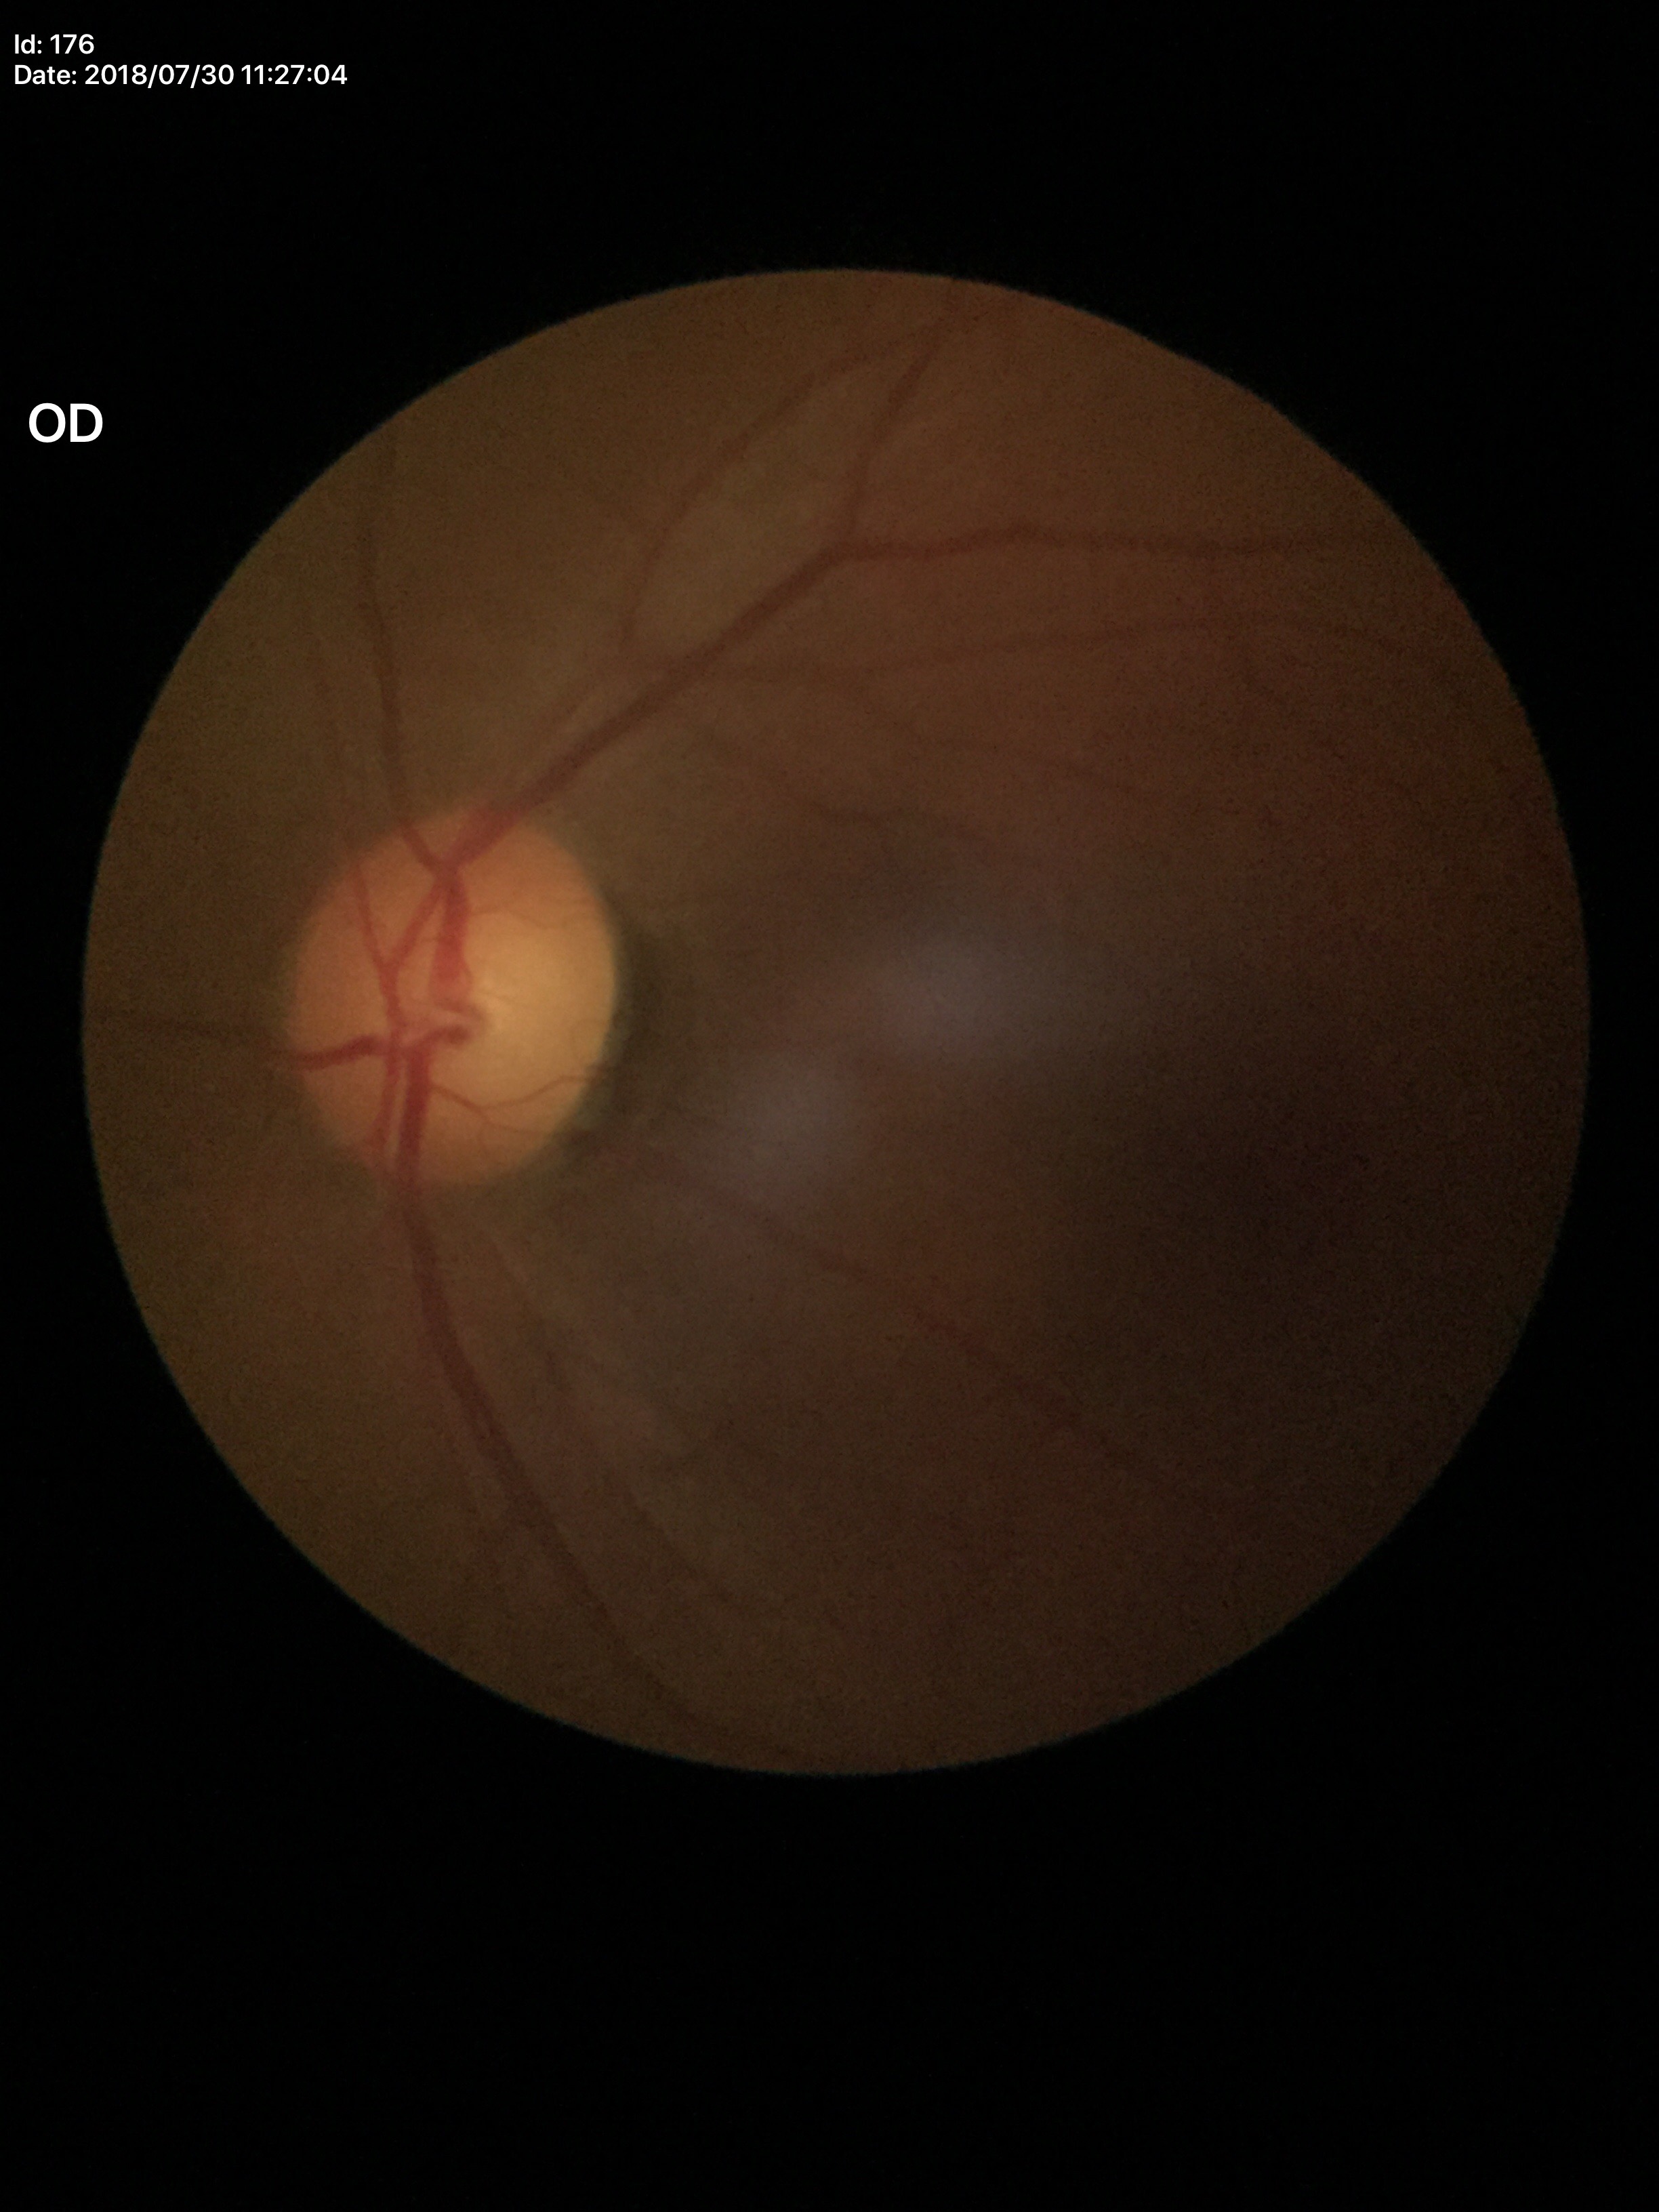
Q: Vertical CDR?
A: 0.54
Q: What is the area cup-to-disc ratio?
A: 0.30
Q: Glaucoma screening result?
A: not suspect